Infant wide-field fundus photograph — 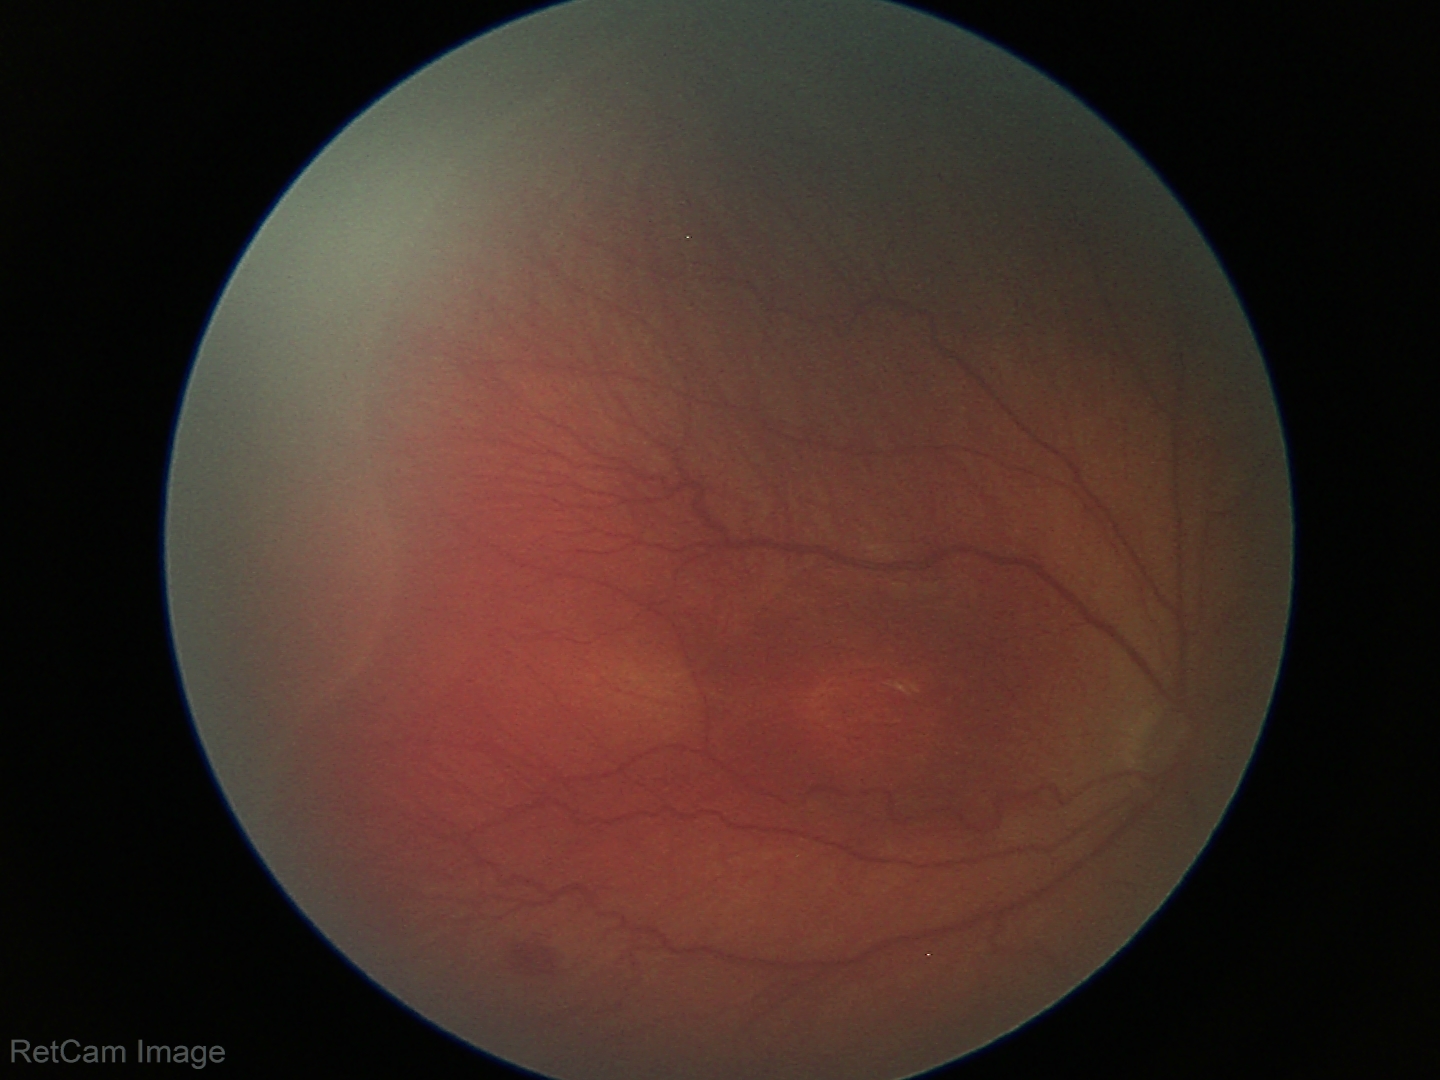
Examination diagnosed as retinopathy of prematurity (ROP) stage 3.
Plus disease absent.